Modified Davis classification.
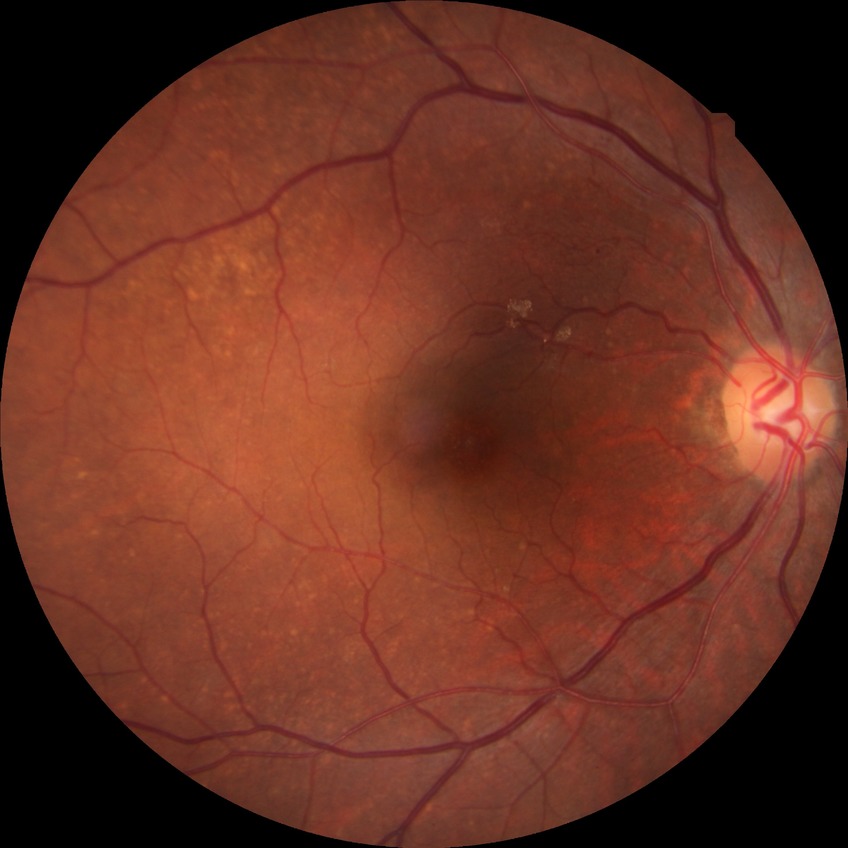 Annotations:
* diabetic retinopathy (DR) — simple diabetic retinopathy (SDR)